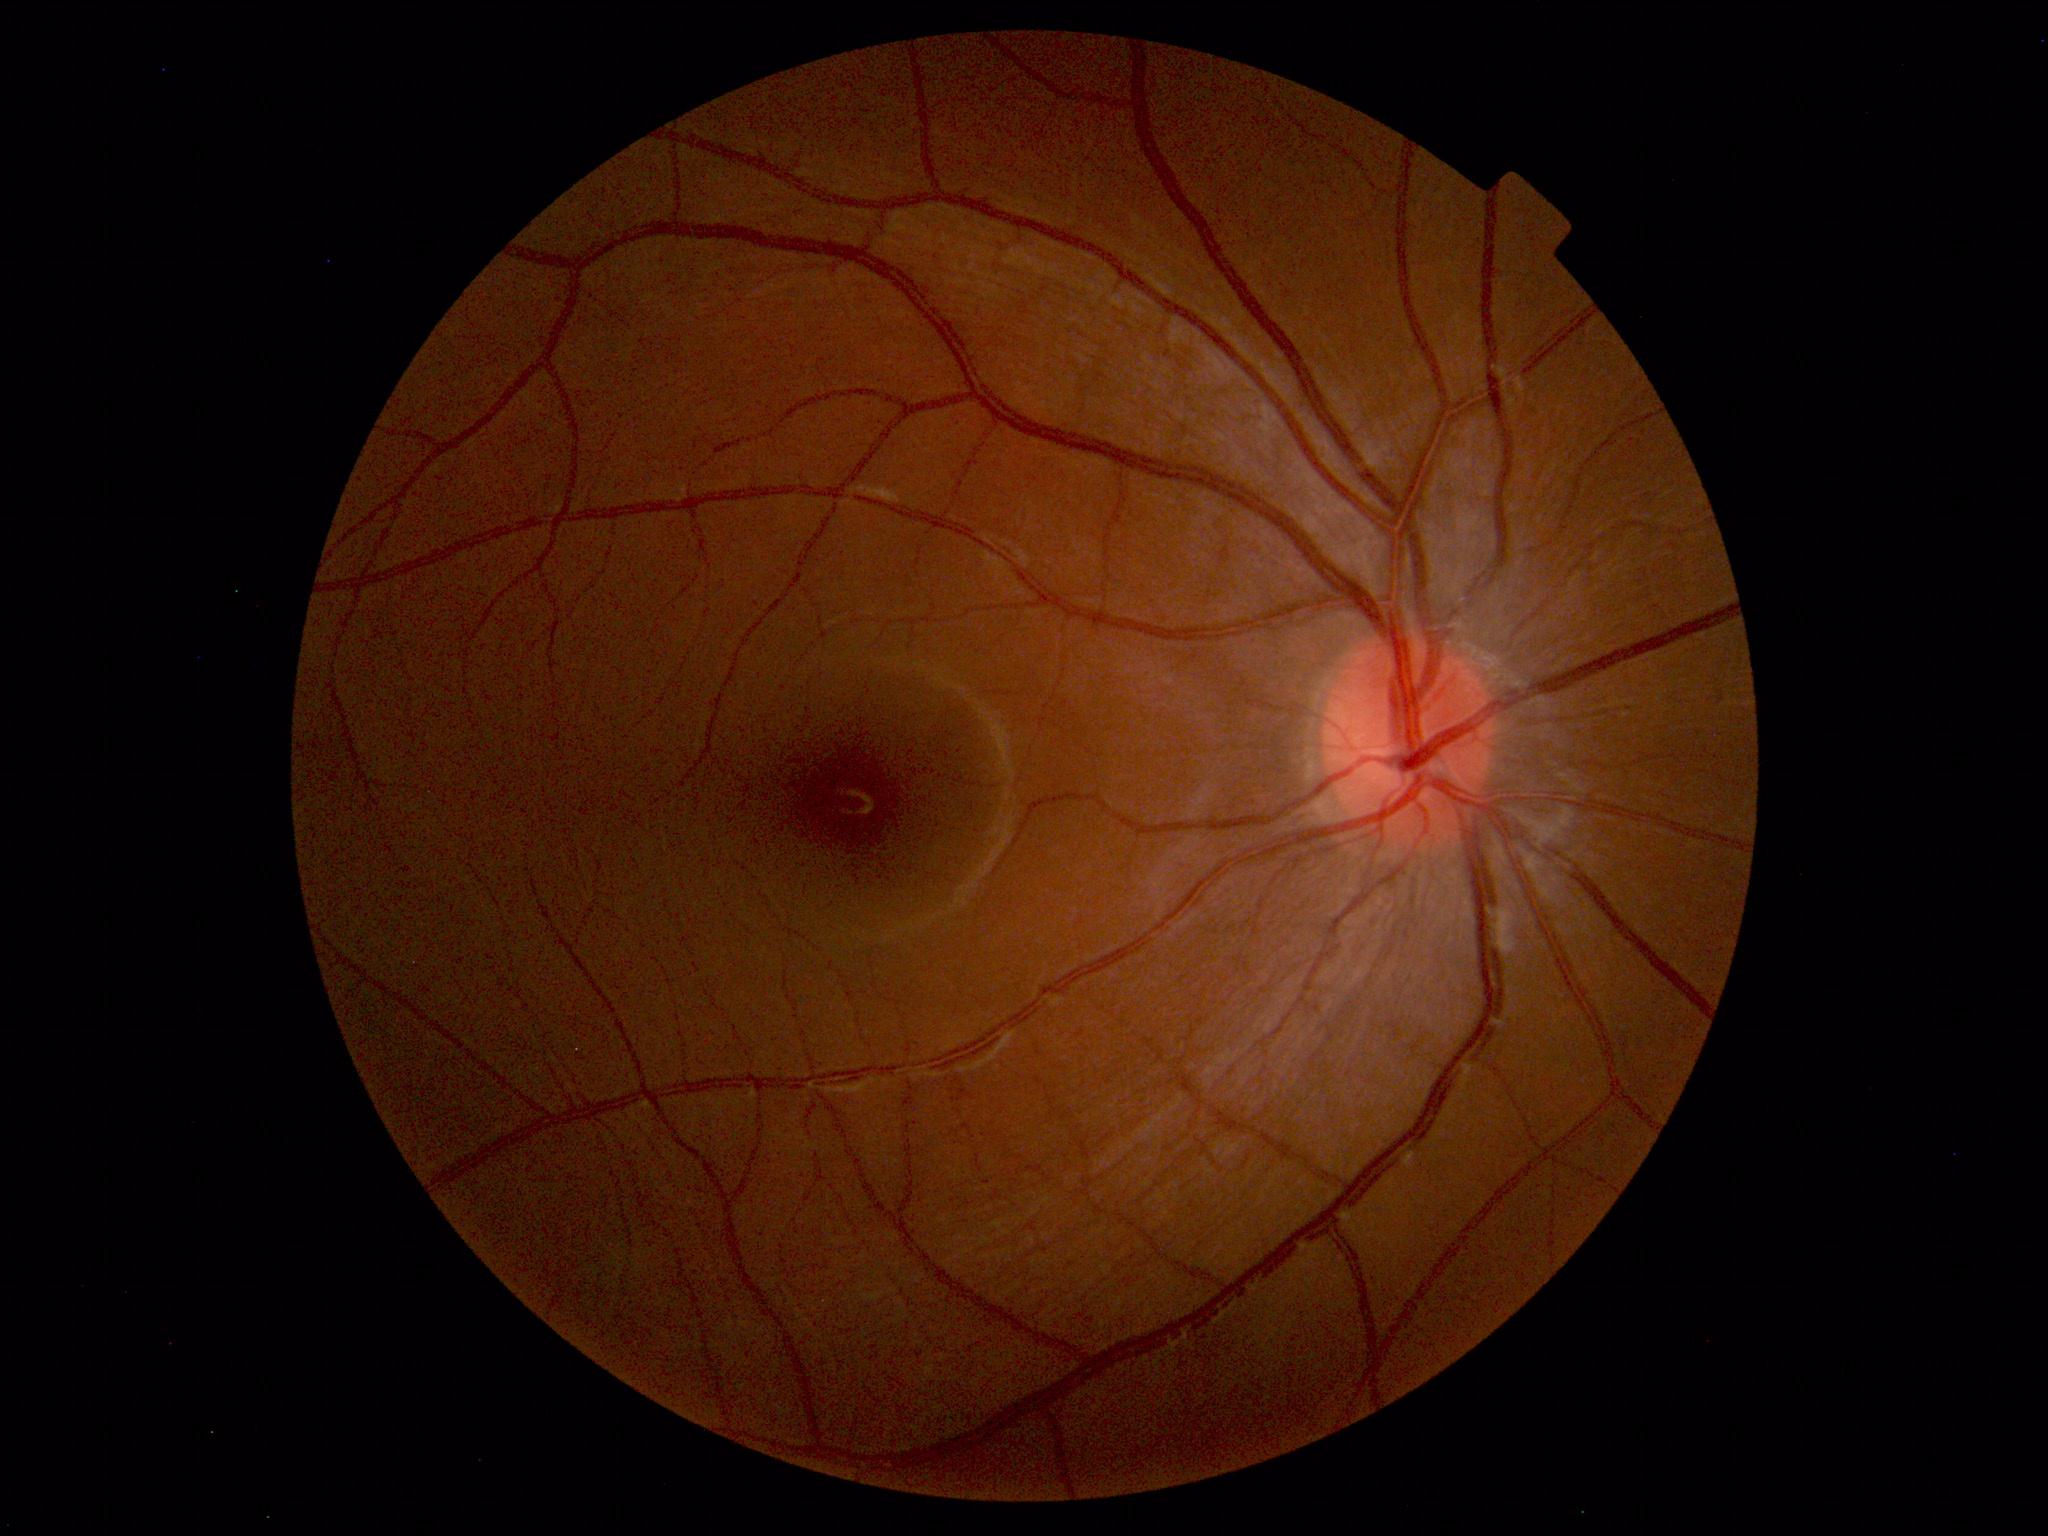

Normal fundus. No pathology identified.